Kowa VX-10α:
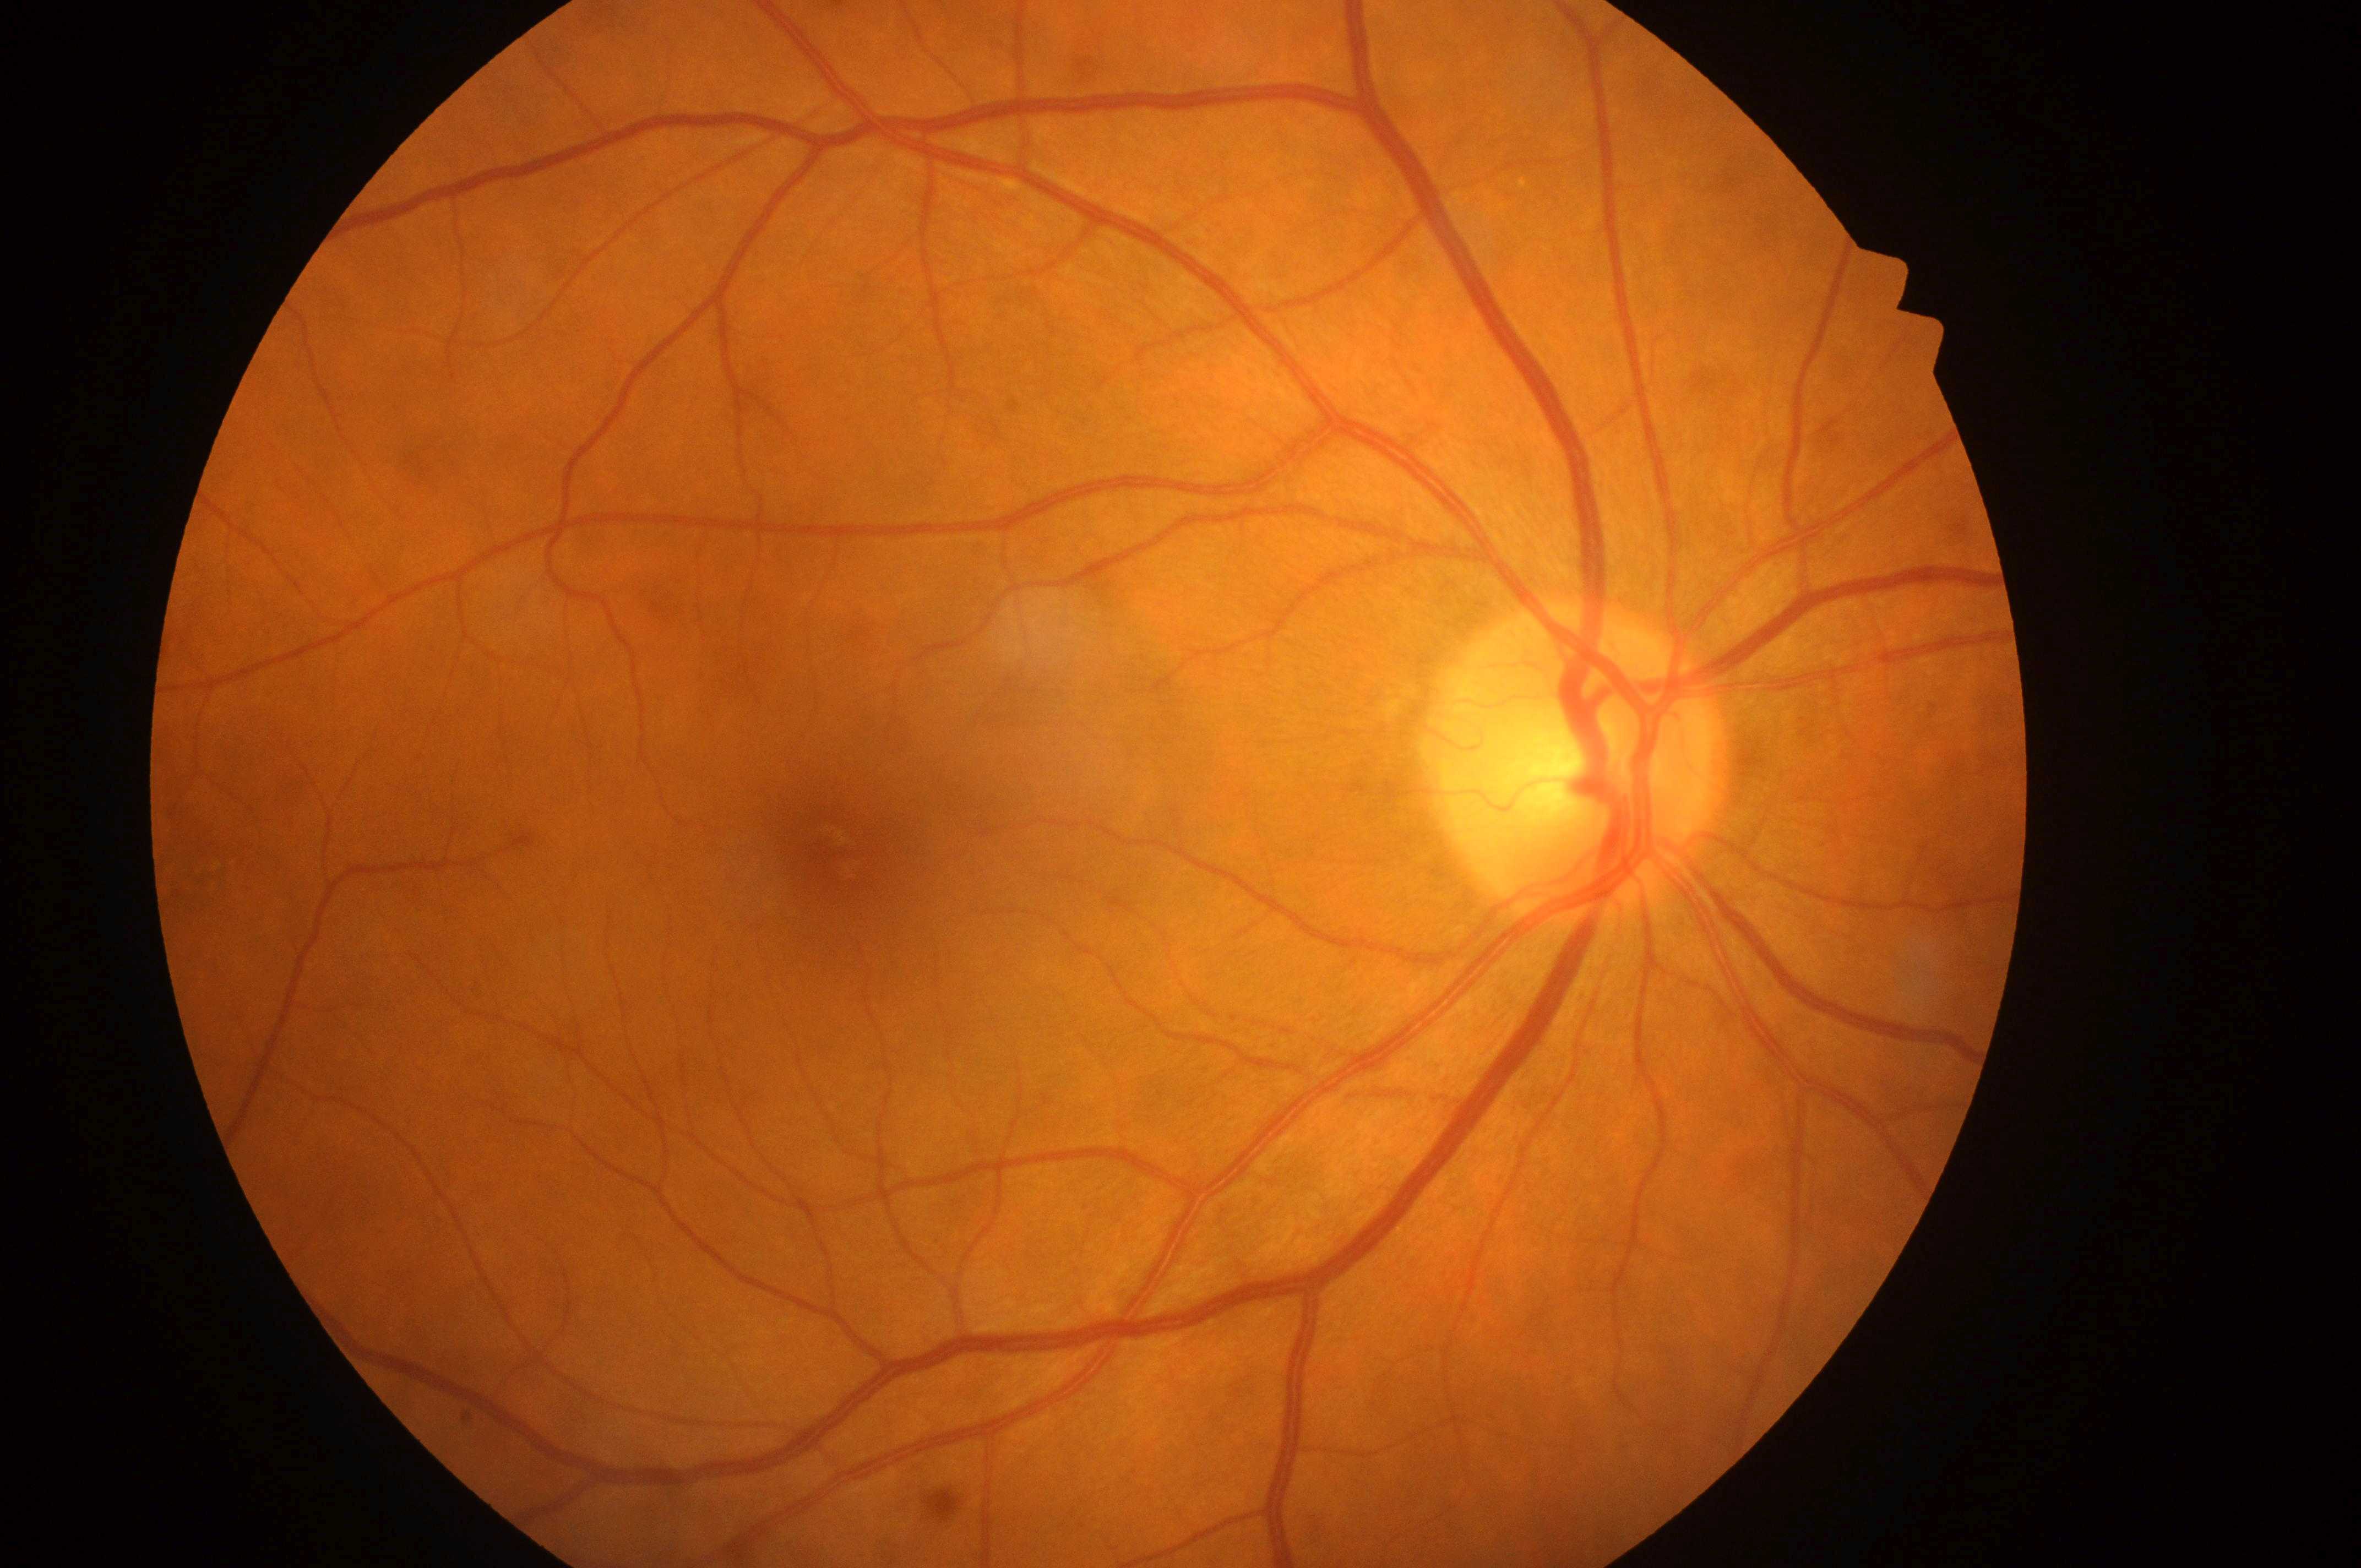

Fovea: (x: 837, y: 850). Imaged eye: OD. DME is grade 0 (no risk). Disc center located at (x: 1570, y: 775). DR: grade 0 (no apparent retinopathy).